1440x1080px; wide-field fundus photograph of an infant: 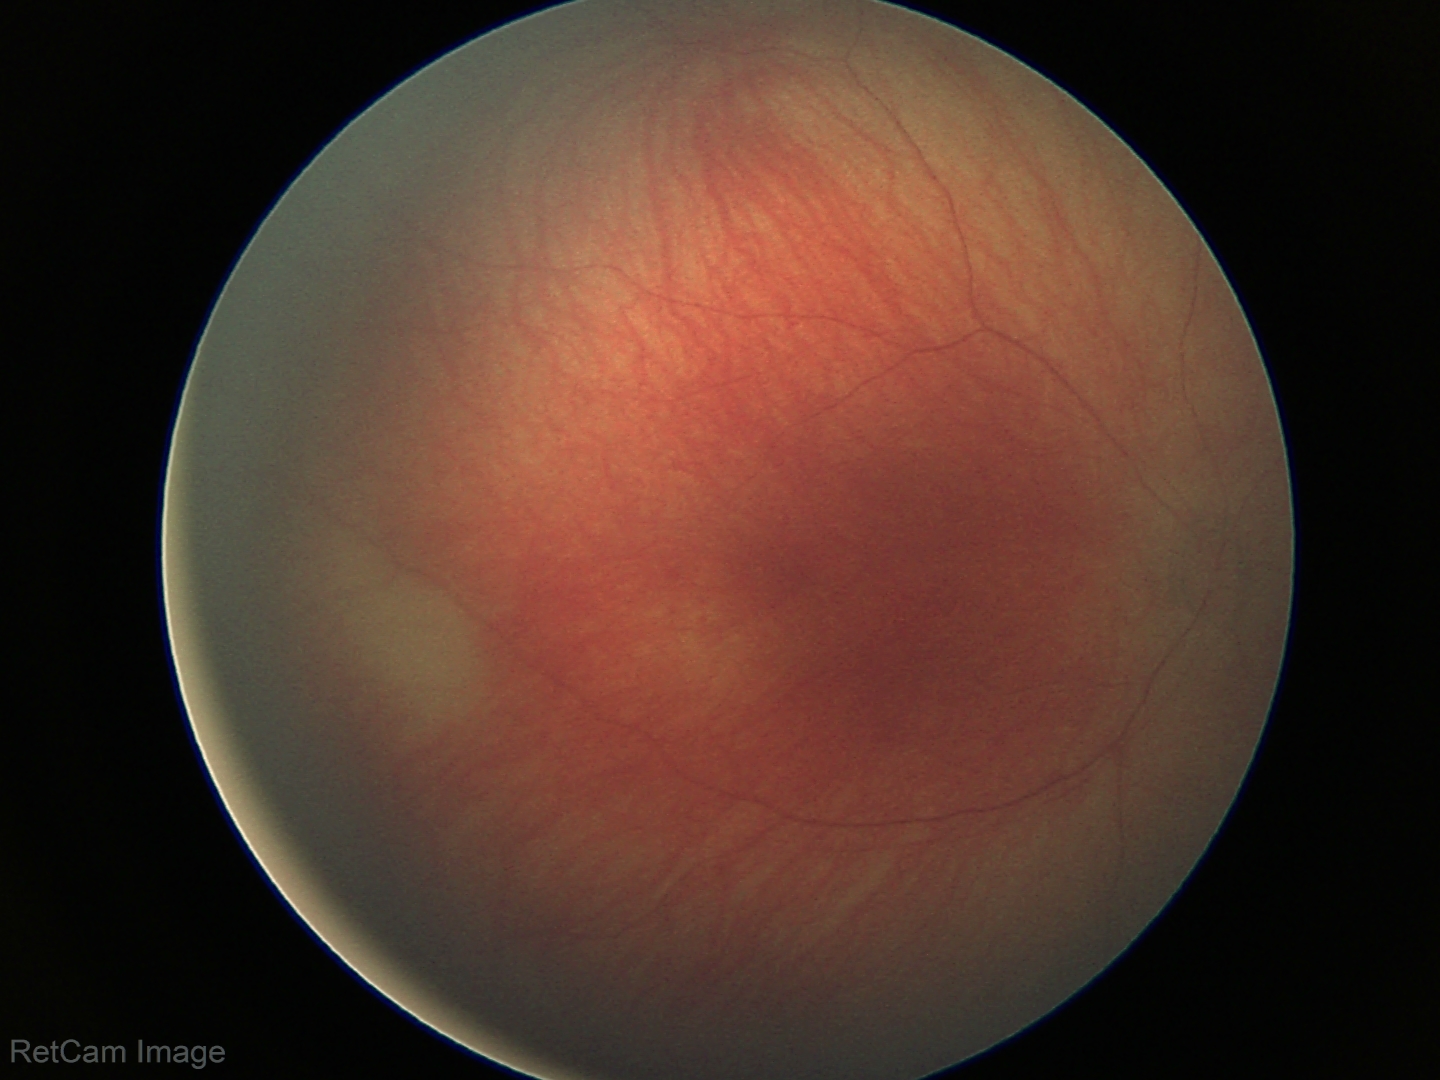 No retinal pathology identified on screening.